2184x1690, fundus photo, FOV: 45 degrees: 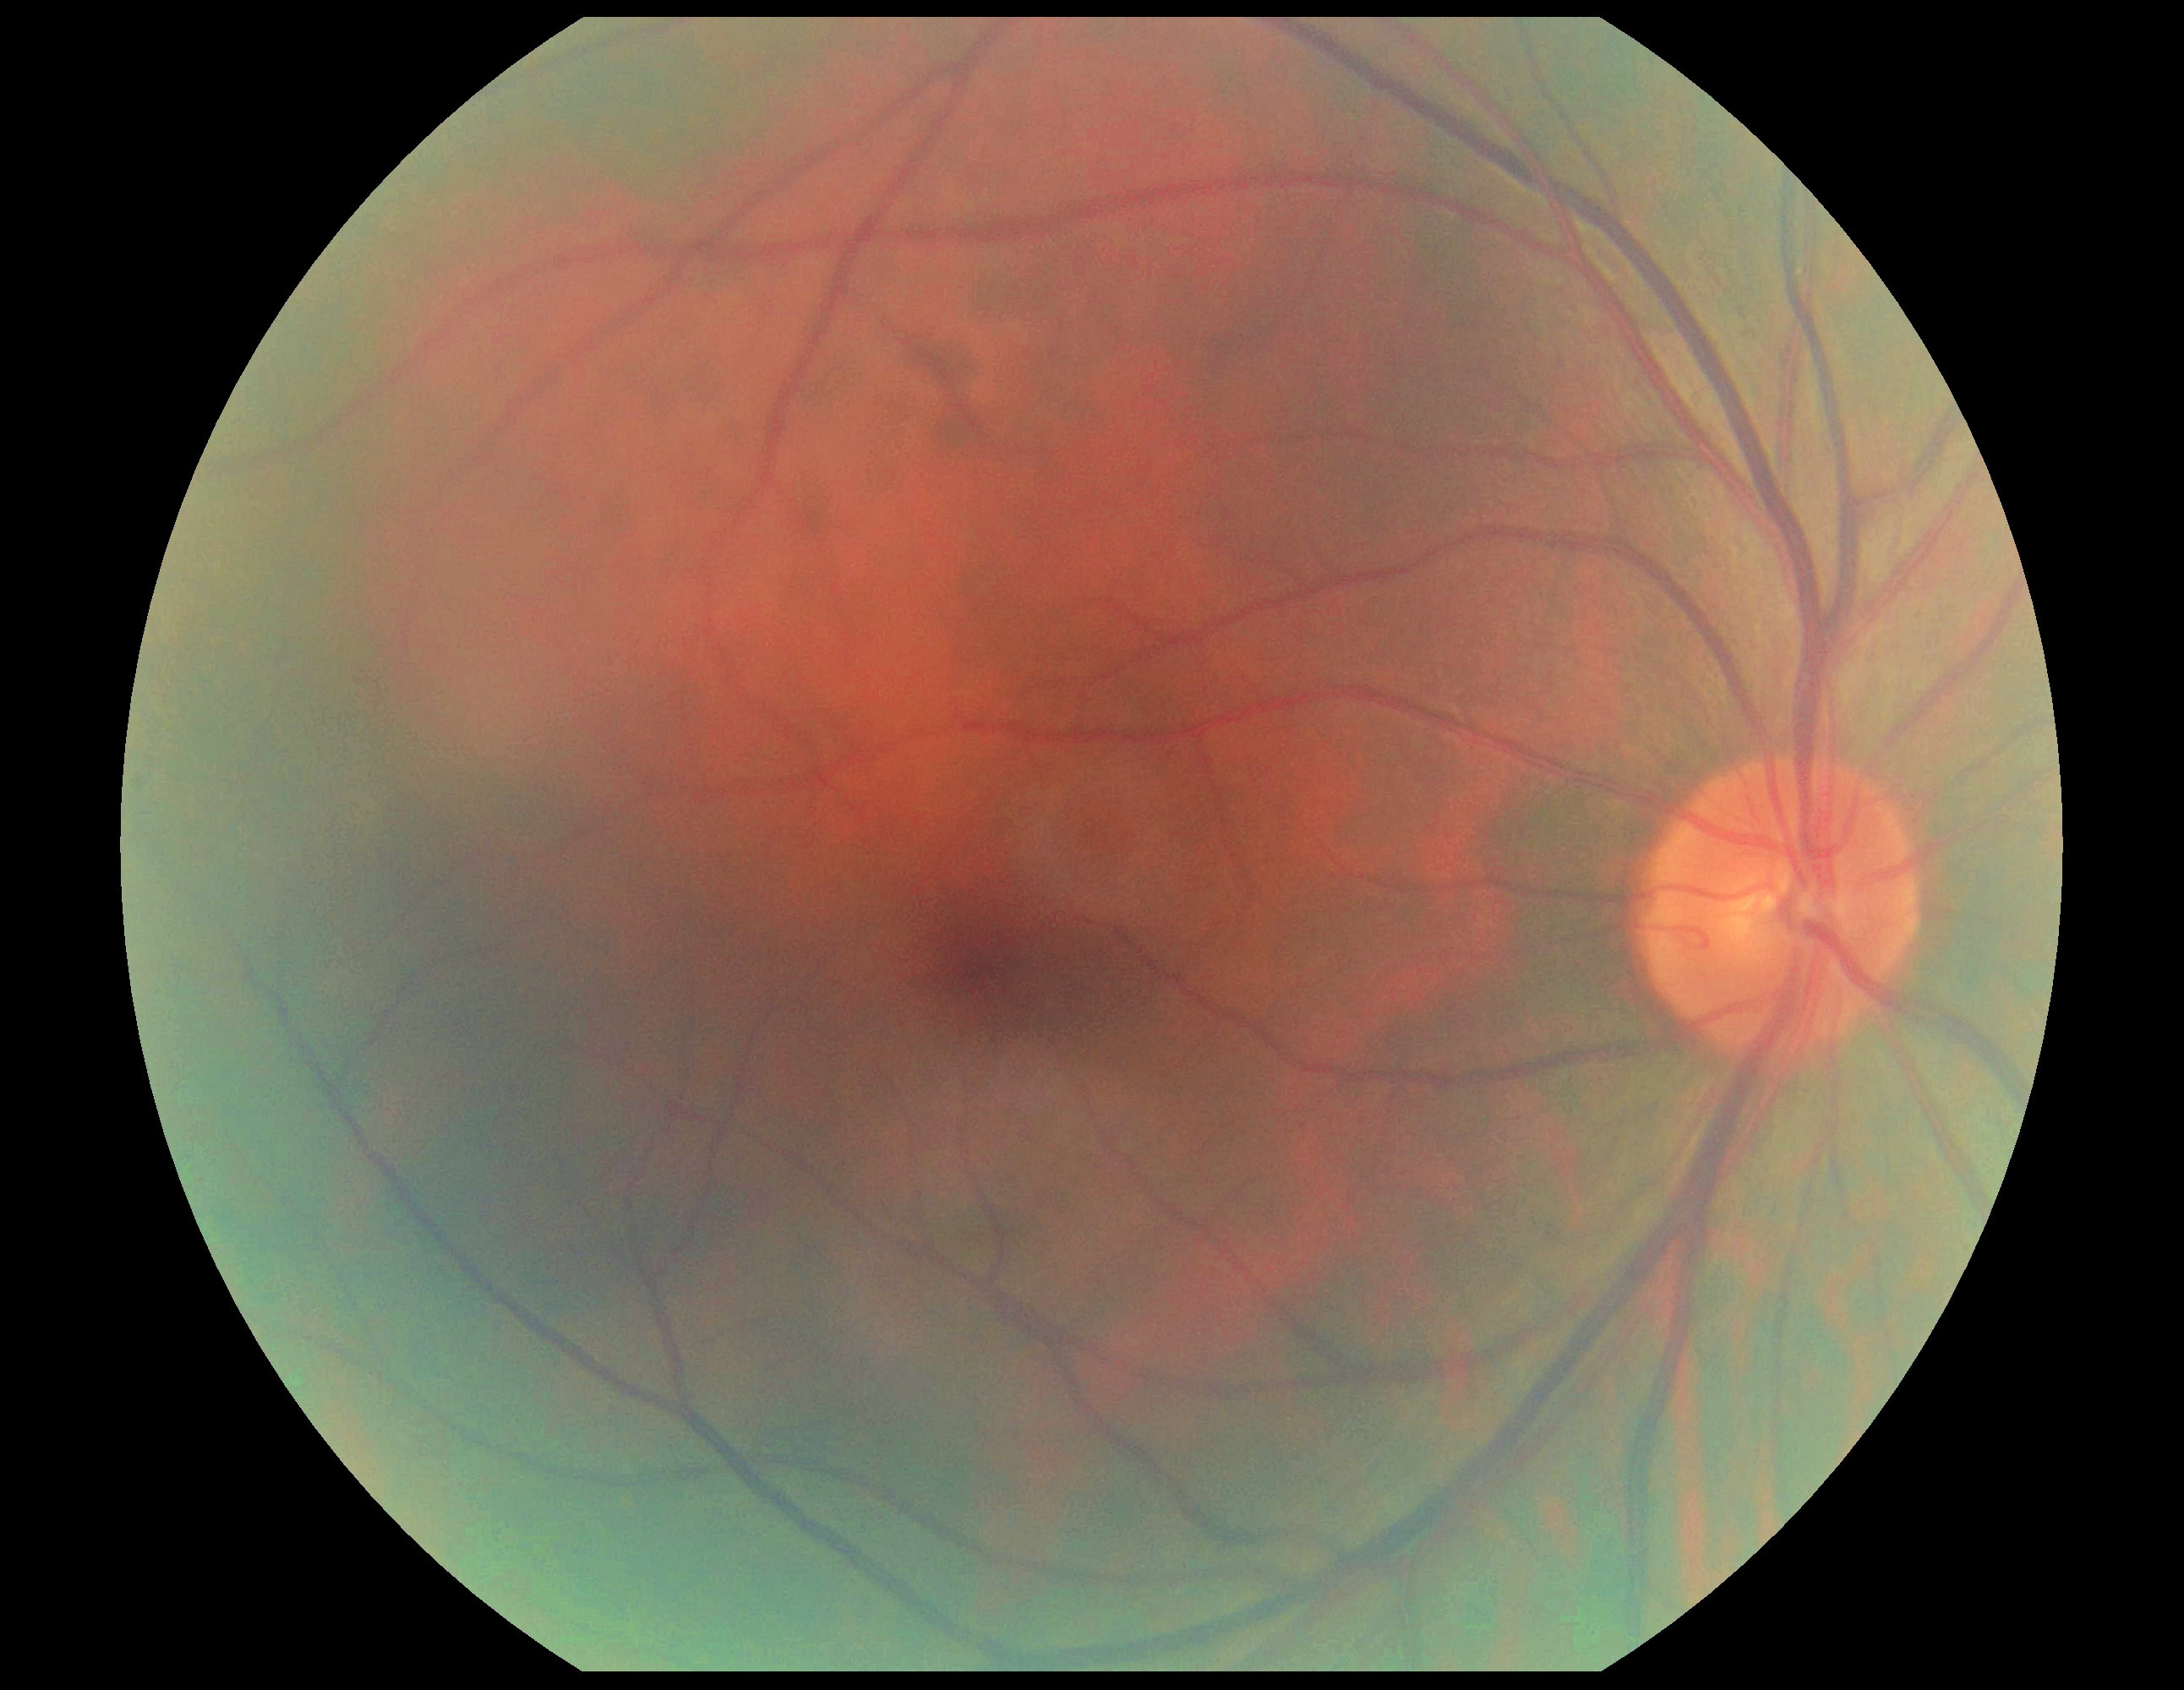 {"dr_grade": "no apparent retinopathy (grade 0)"}